848 x 848 pixels. CFP: 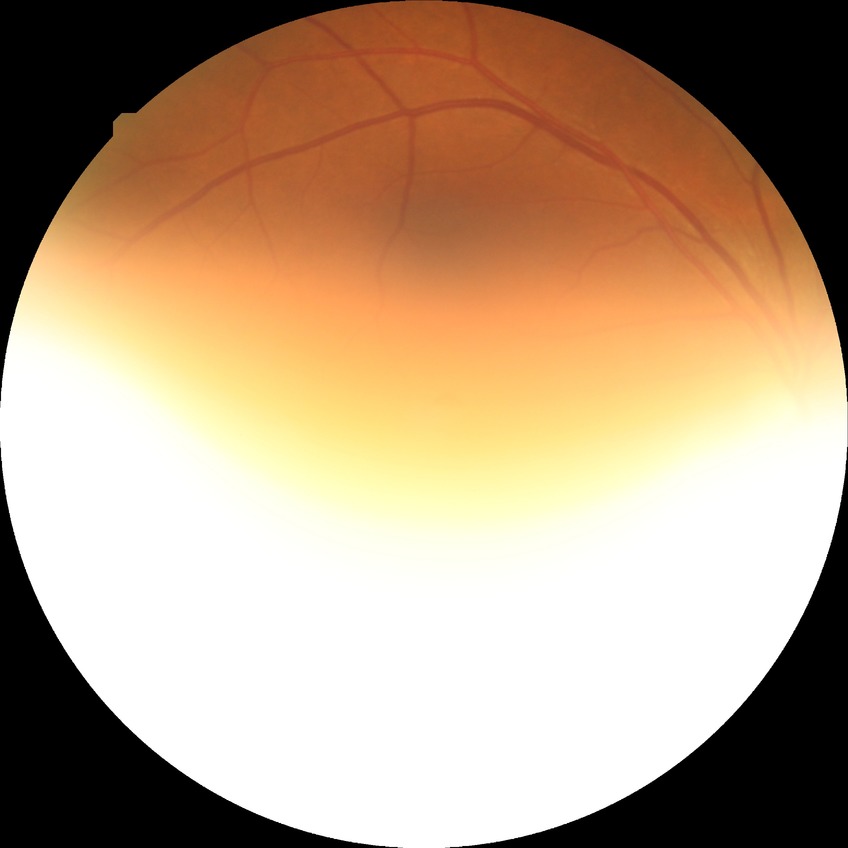
Diabetic retinopathy (DR): NDR (no diabetic retinopathy).